Disc-centered fundus crop · 760x760px — 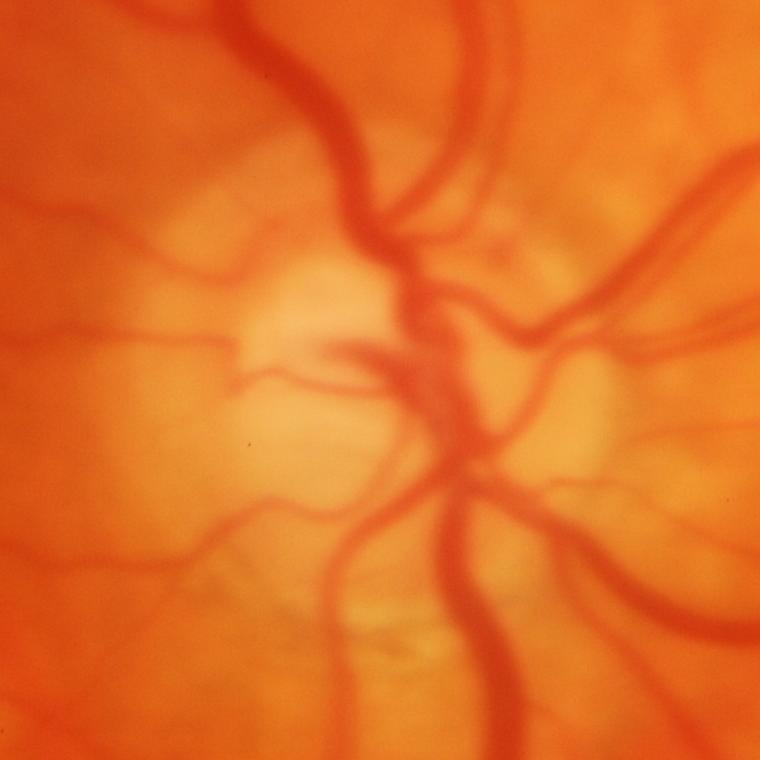

Glaucoma status: glaucomatous findings.